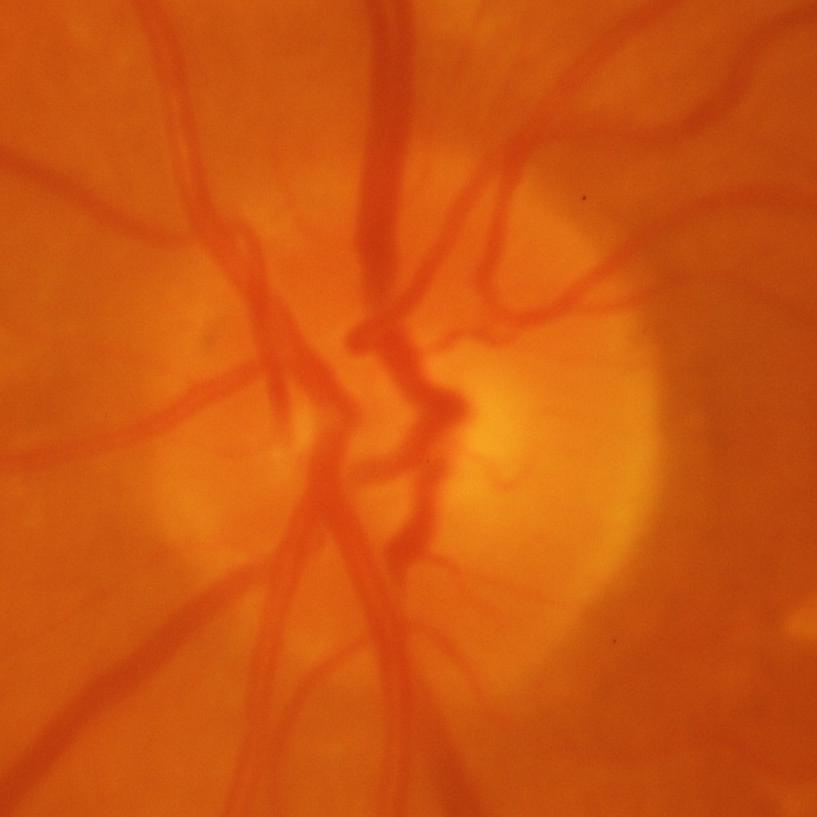 Glaucomatous optic neuropathy is present. Findings consistent with glaucomatous damage to the optic nerve.